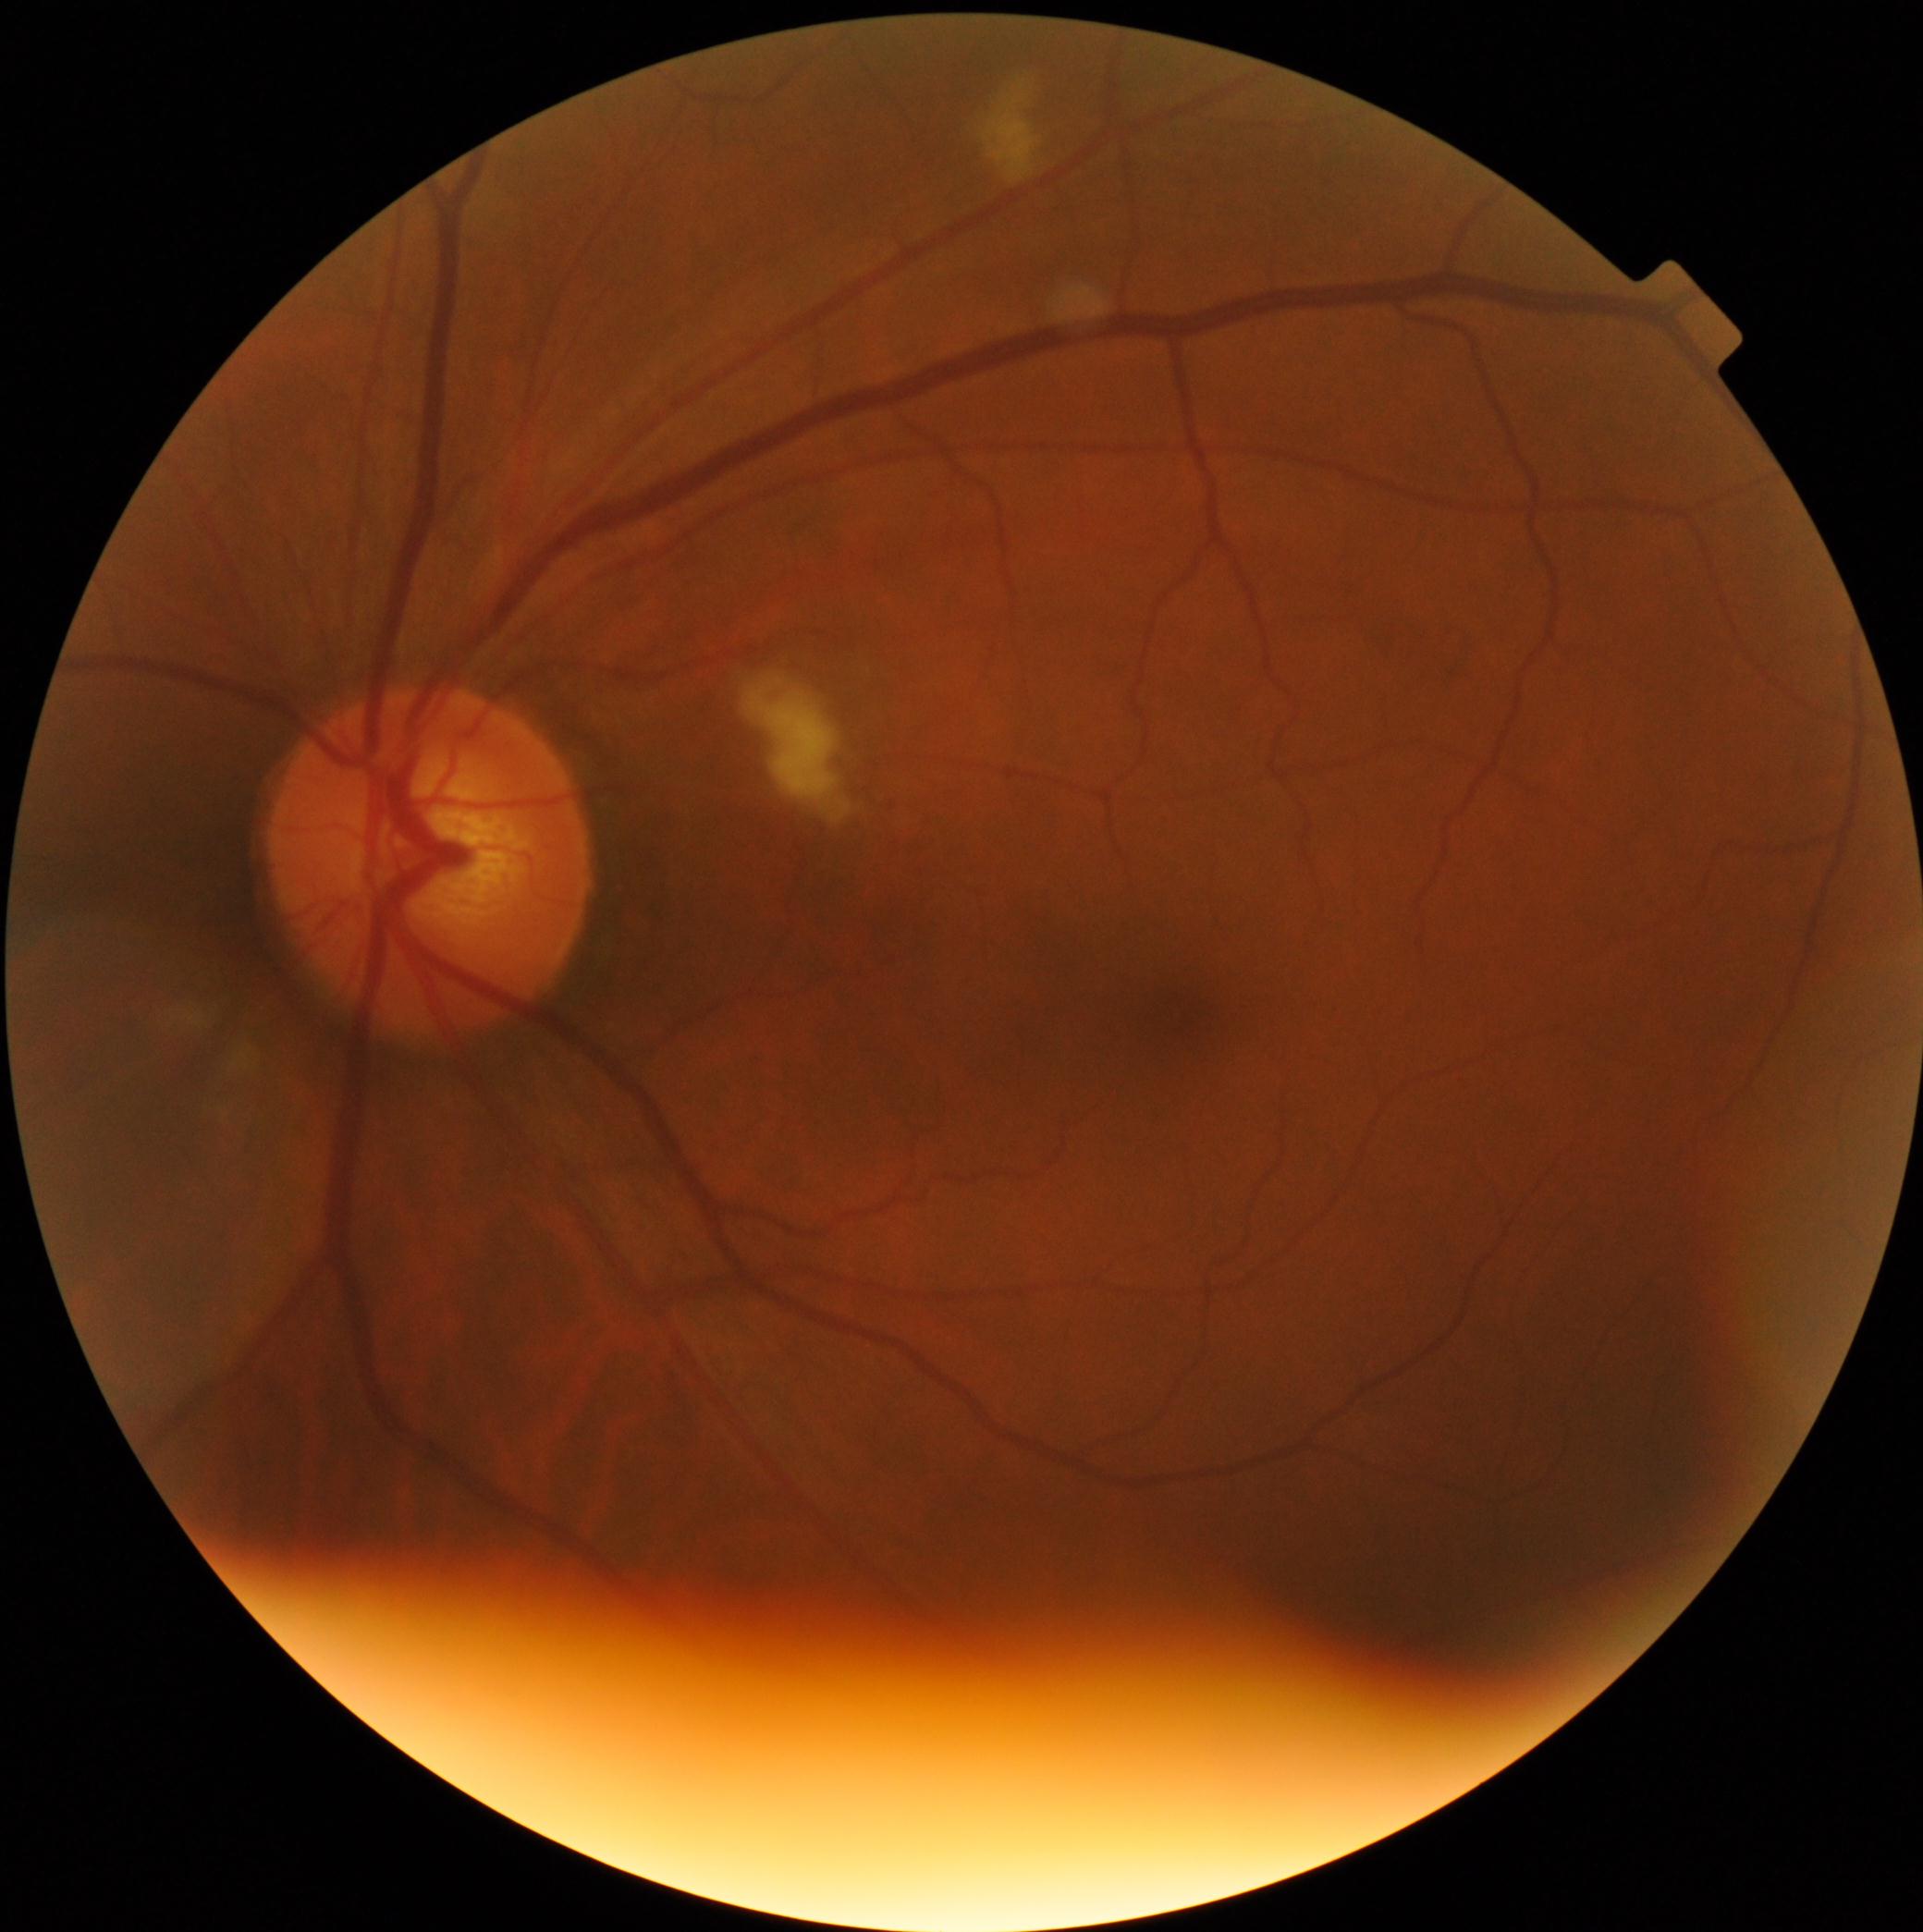

Diabetic retinopathy is 2.